Image size 2352x1568 · color fundus photograph · 45-degree field of view: 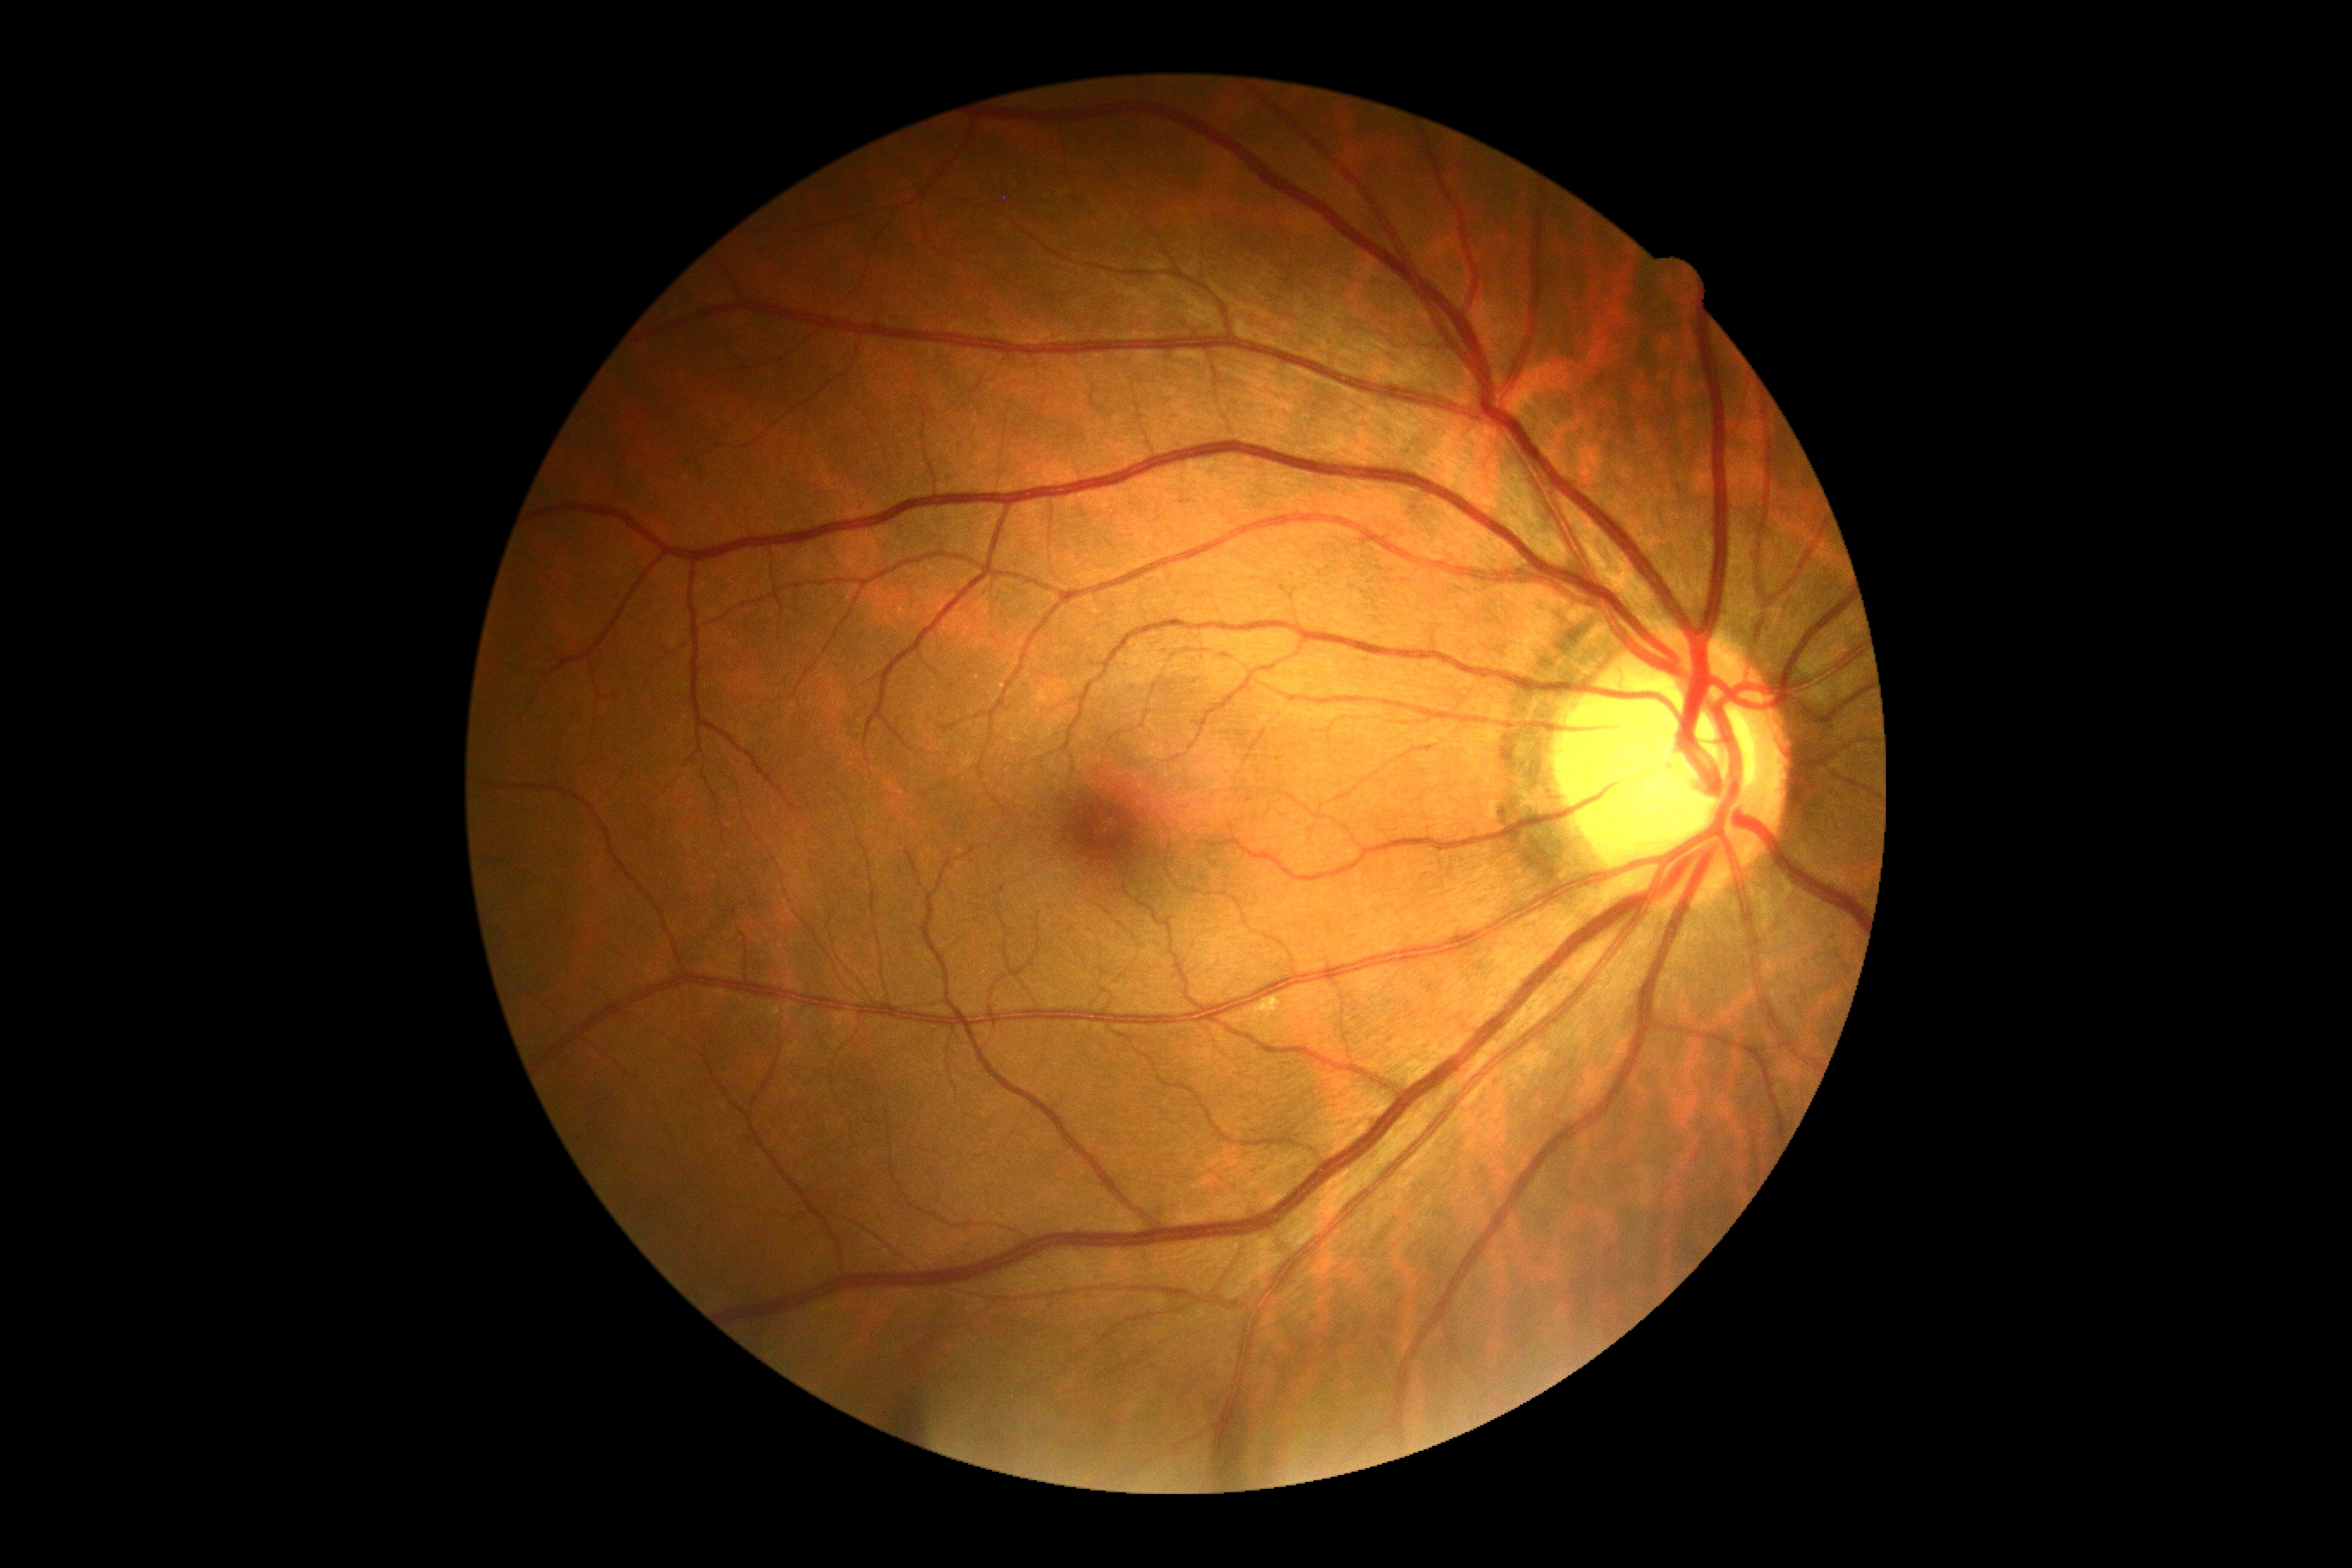 DR: grade 0 (no apparent retinopathy).